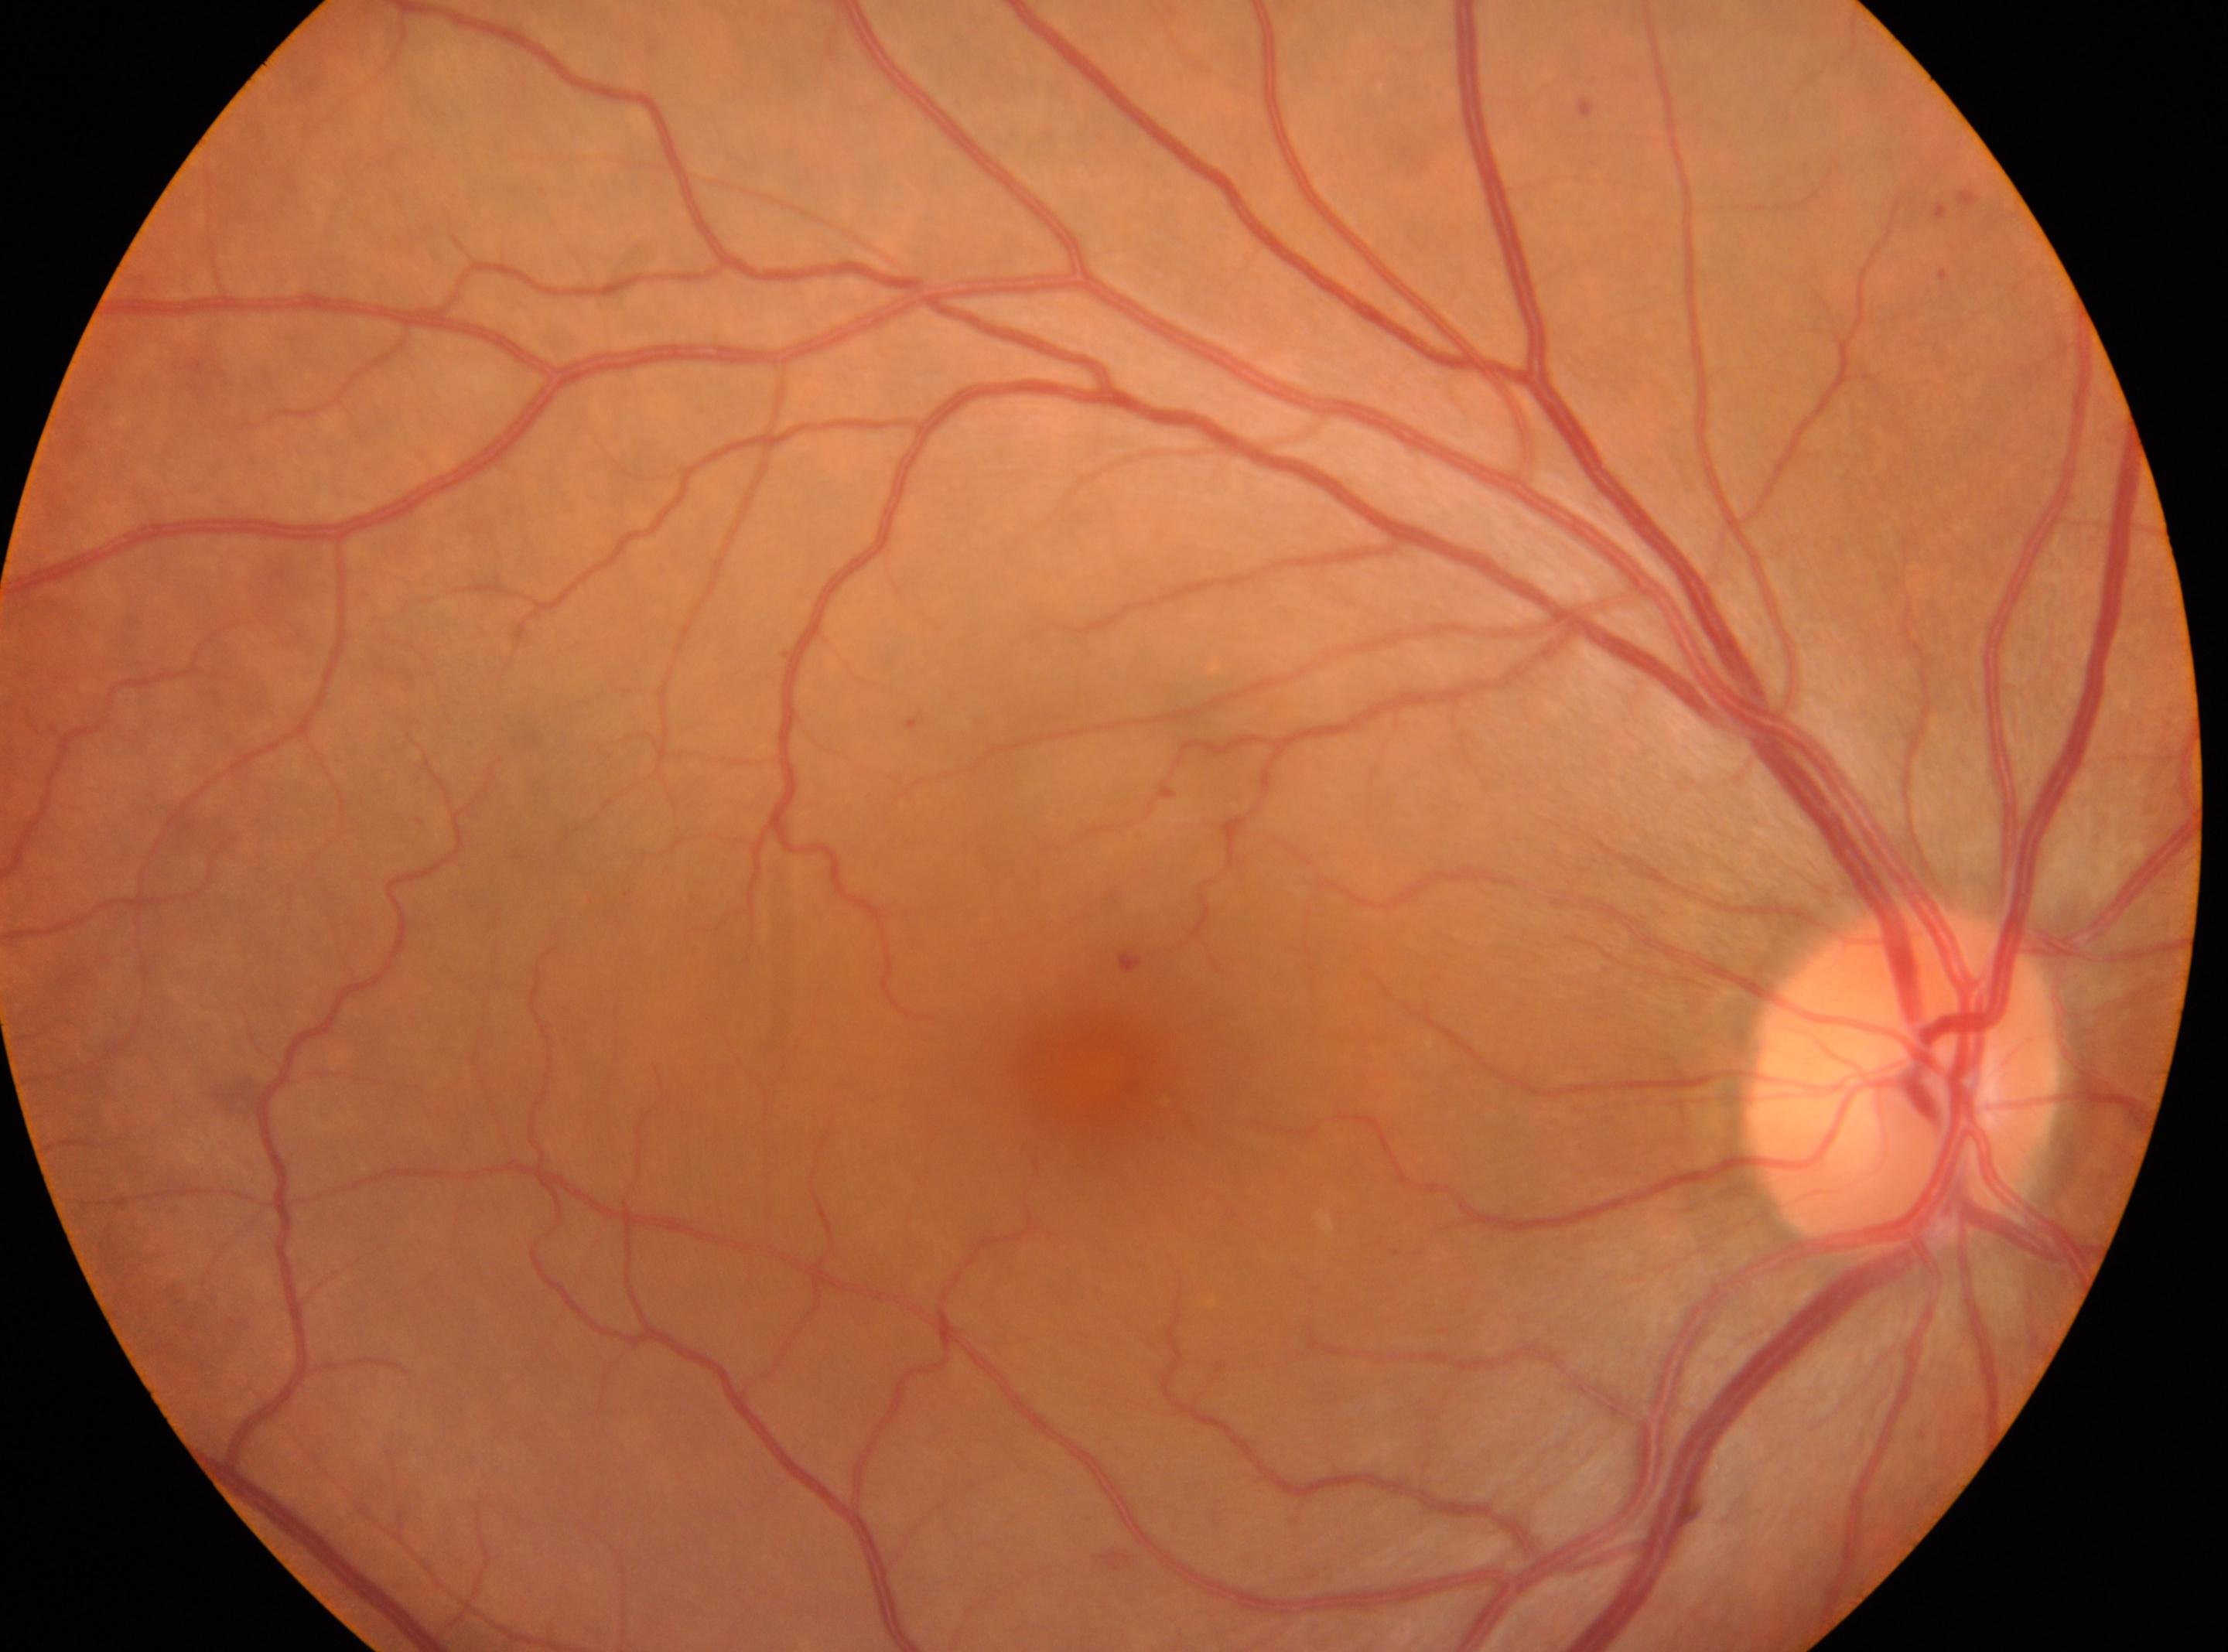

| feature | annotation |
|---|---|
| DR | grade 1 |
| optic nerve head | [1902, 1080] |
| macular center | [1097, 1077] |
| laterality | the right eye |